Retinal fundus photograph: 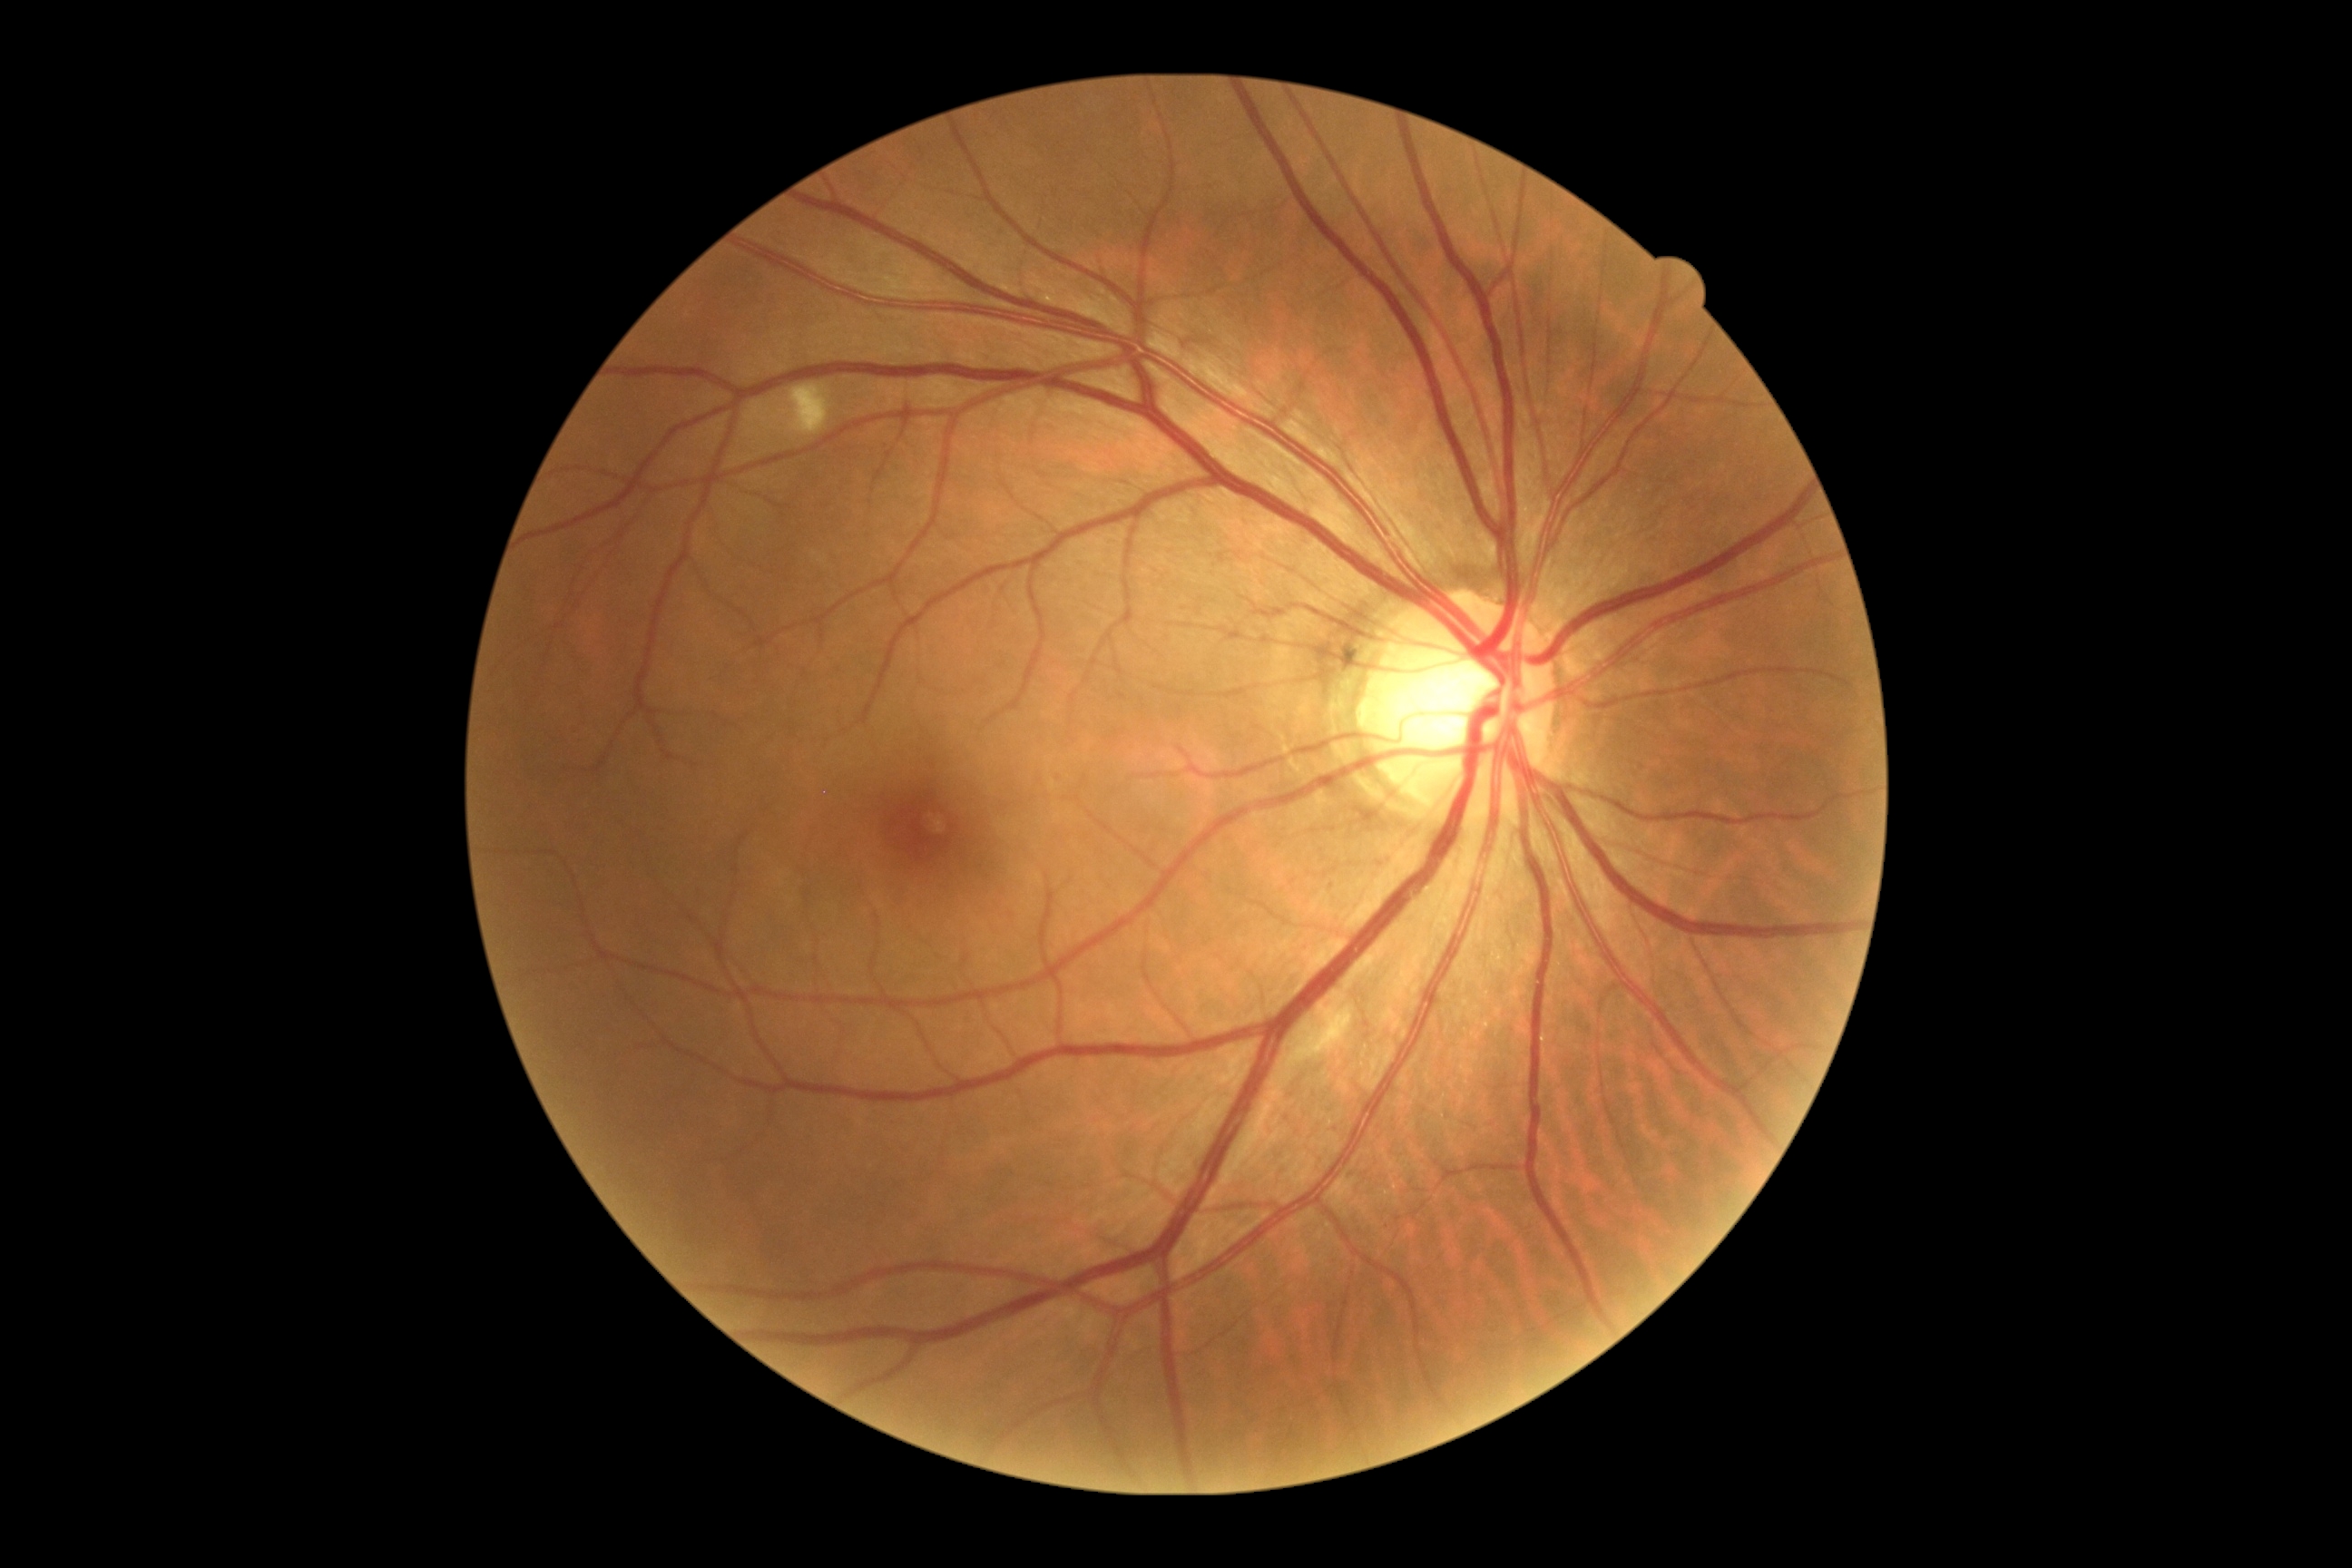

Retinopathy is moderate NPDR (grade 2).